45° field of view.
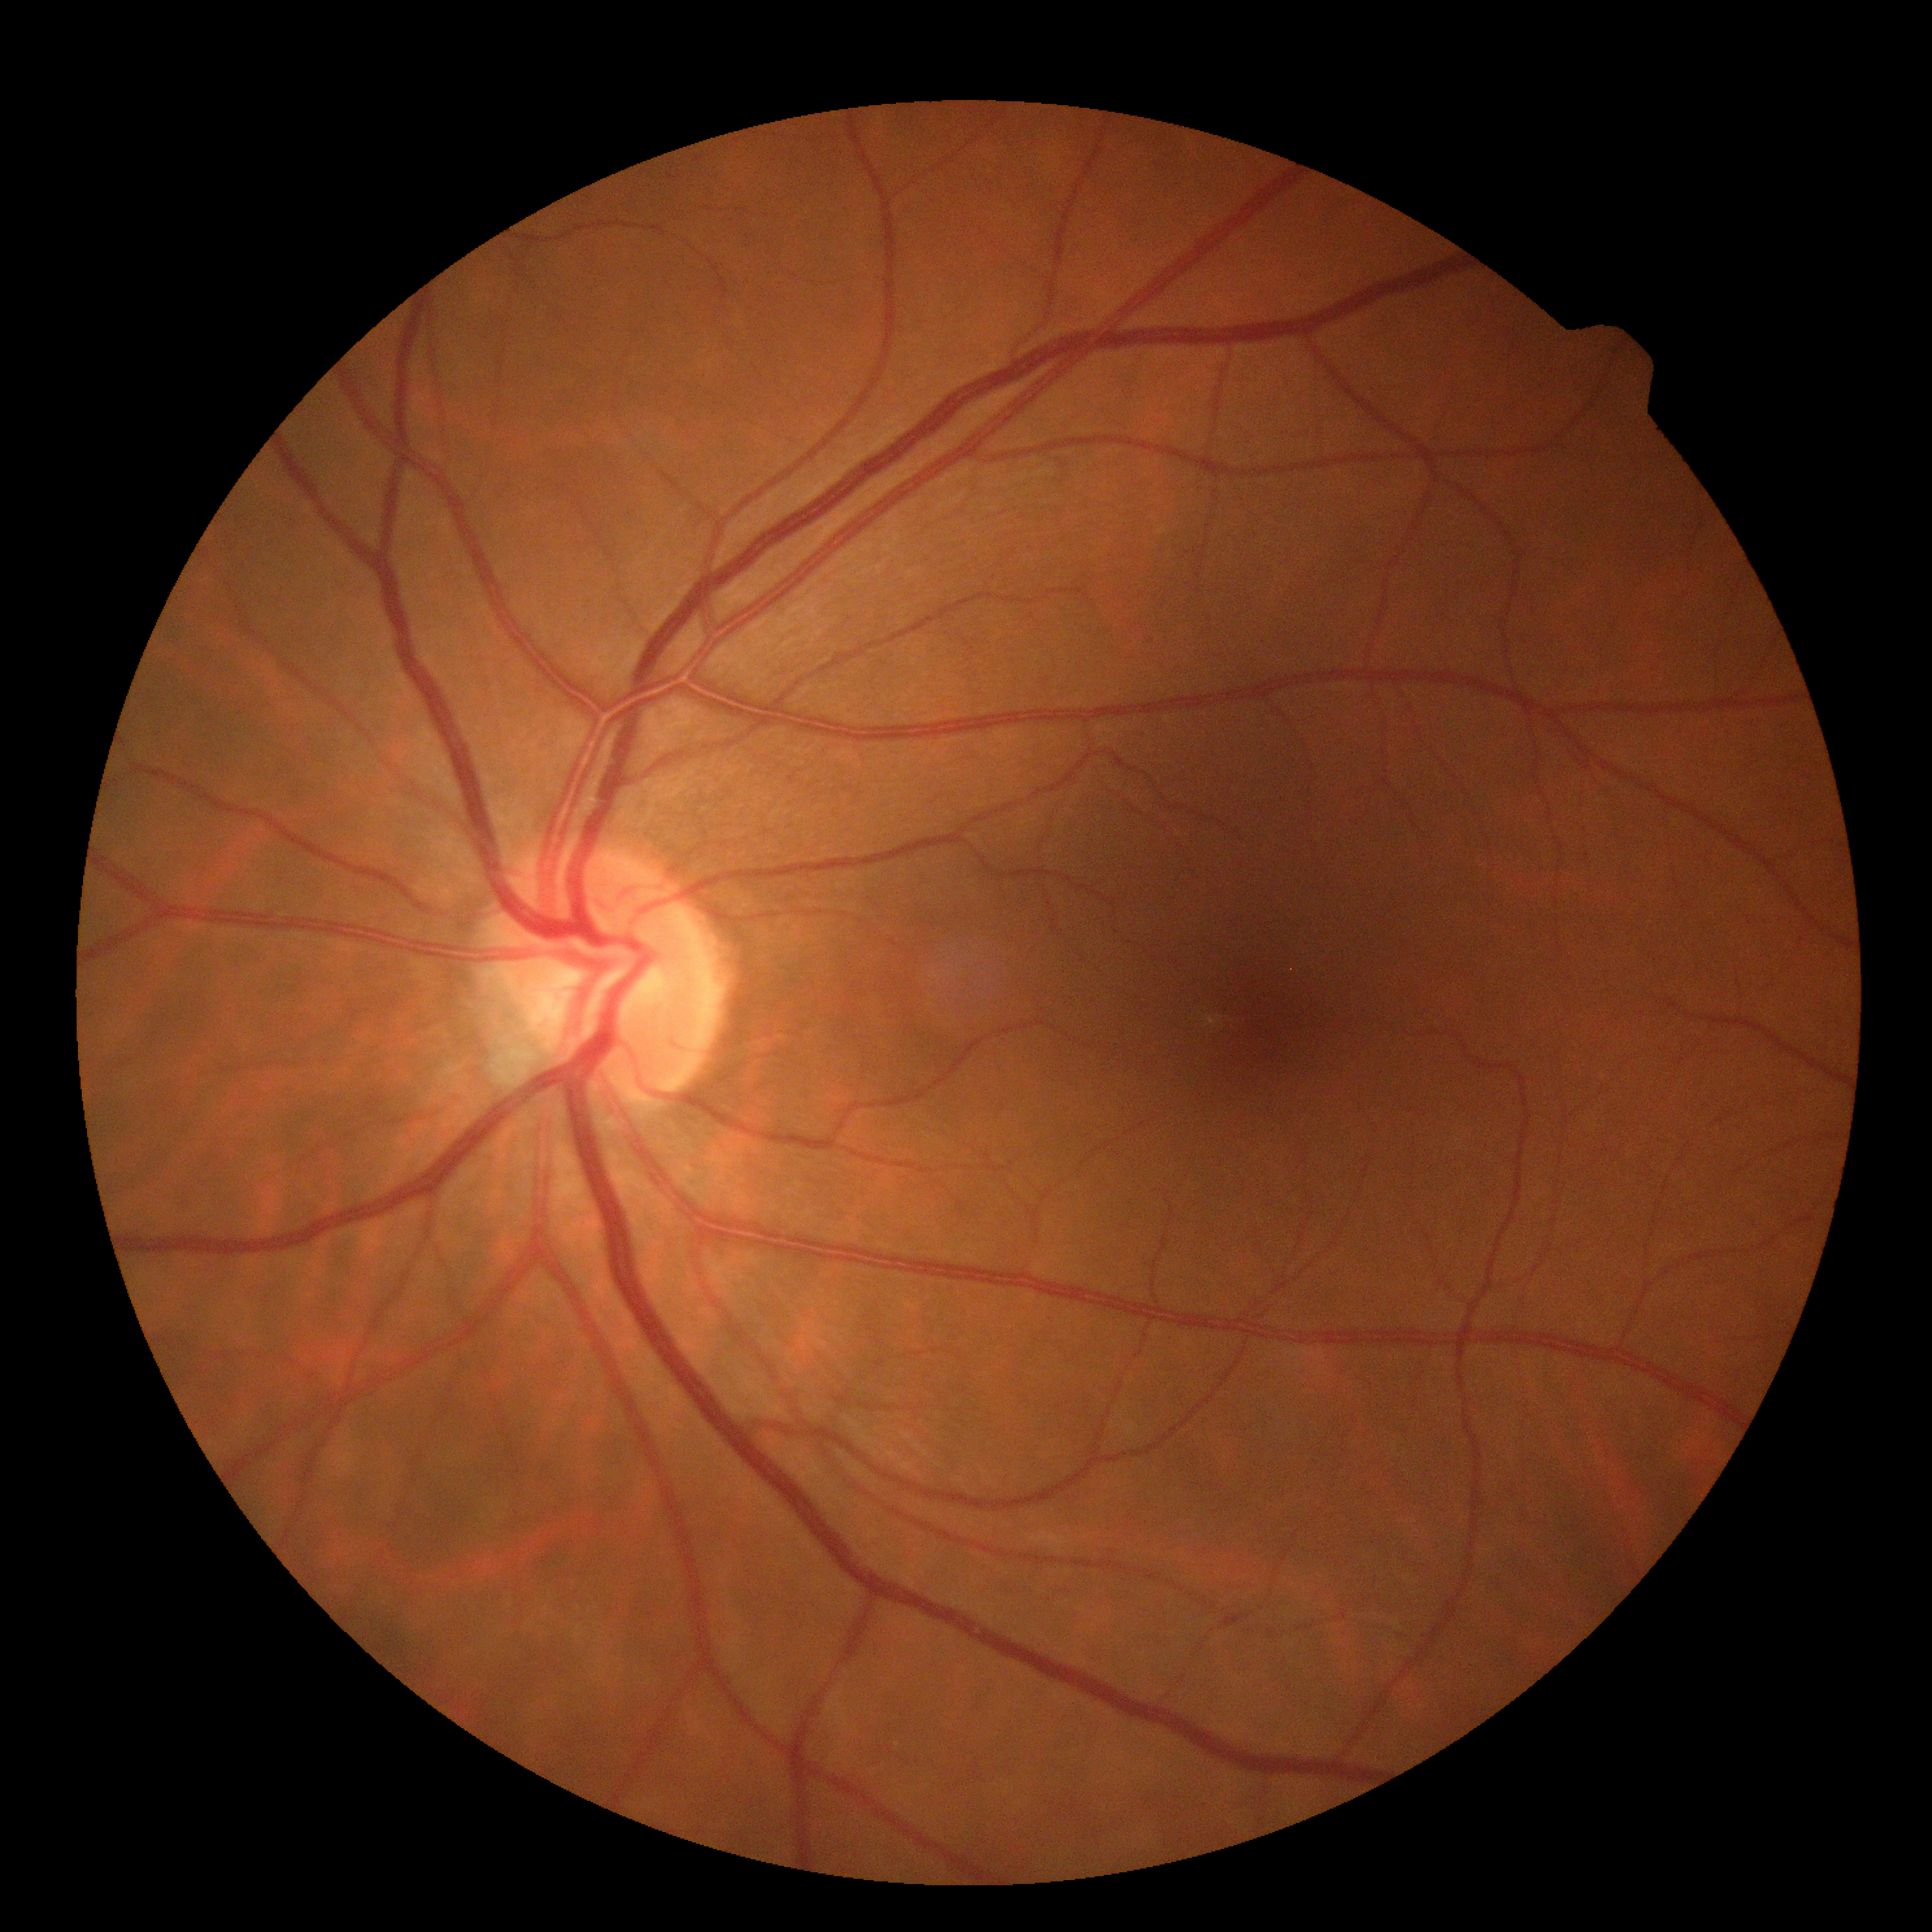
diabetic retinopathy severity=0/4.